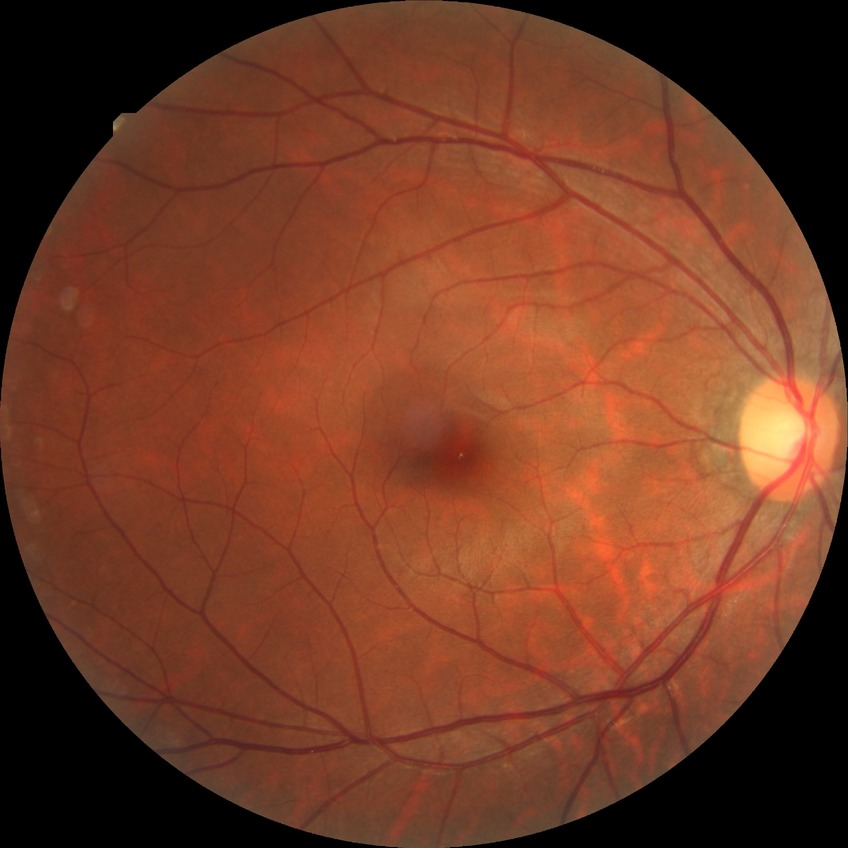
Diabetic retinopathy (DR) is NDR (no diabetic retinopathy).